Optic nerve head photograph
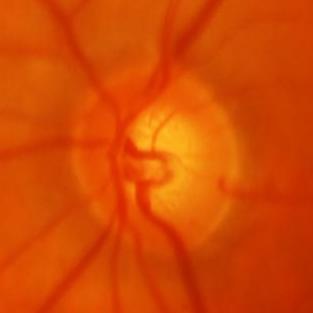
Glaucoma diagnosis = glaucomatous changes.